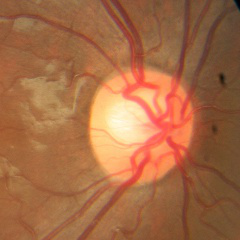

No glaucomatous changes.